1920 x 1440 pixels
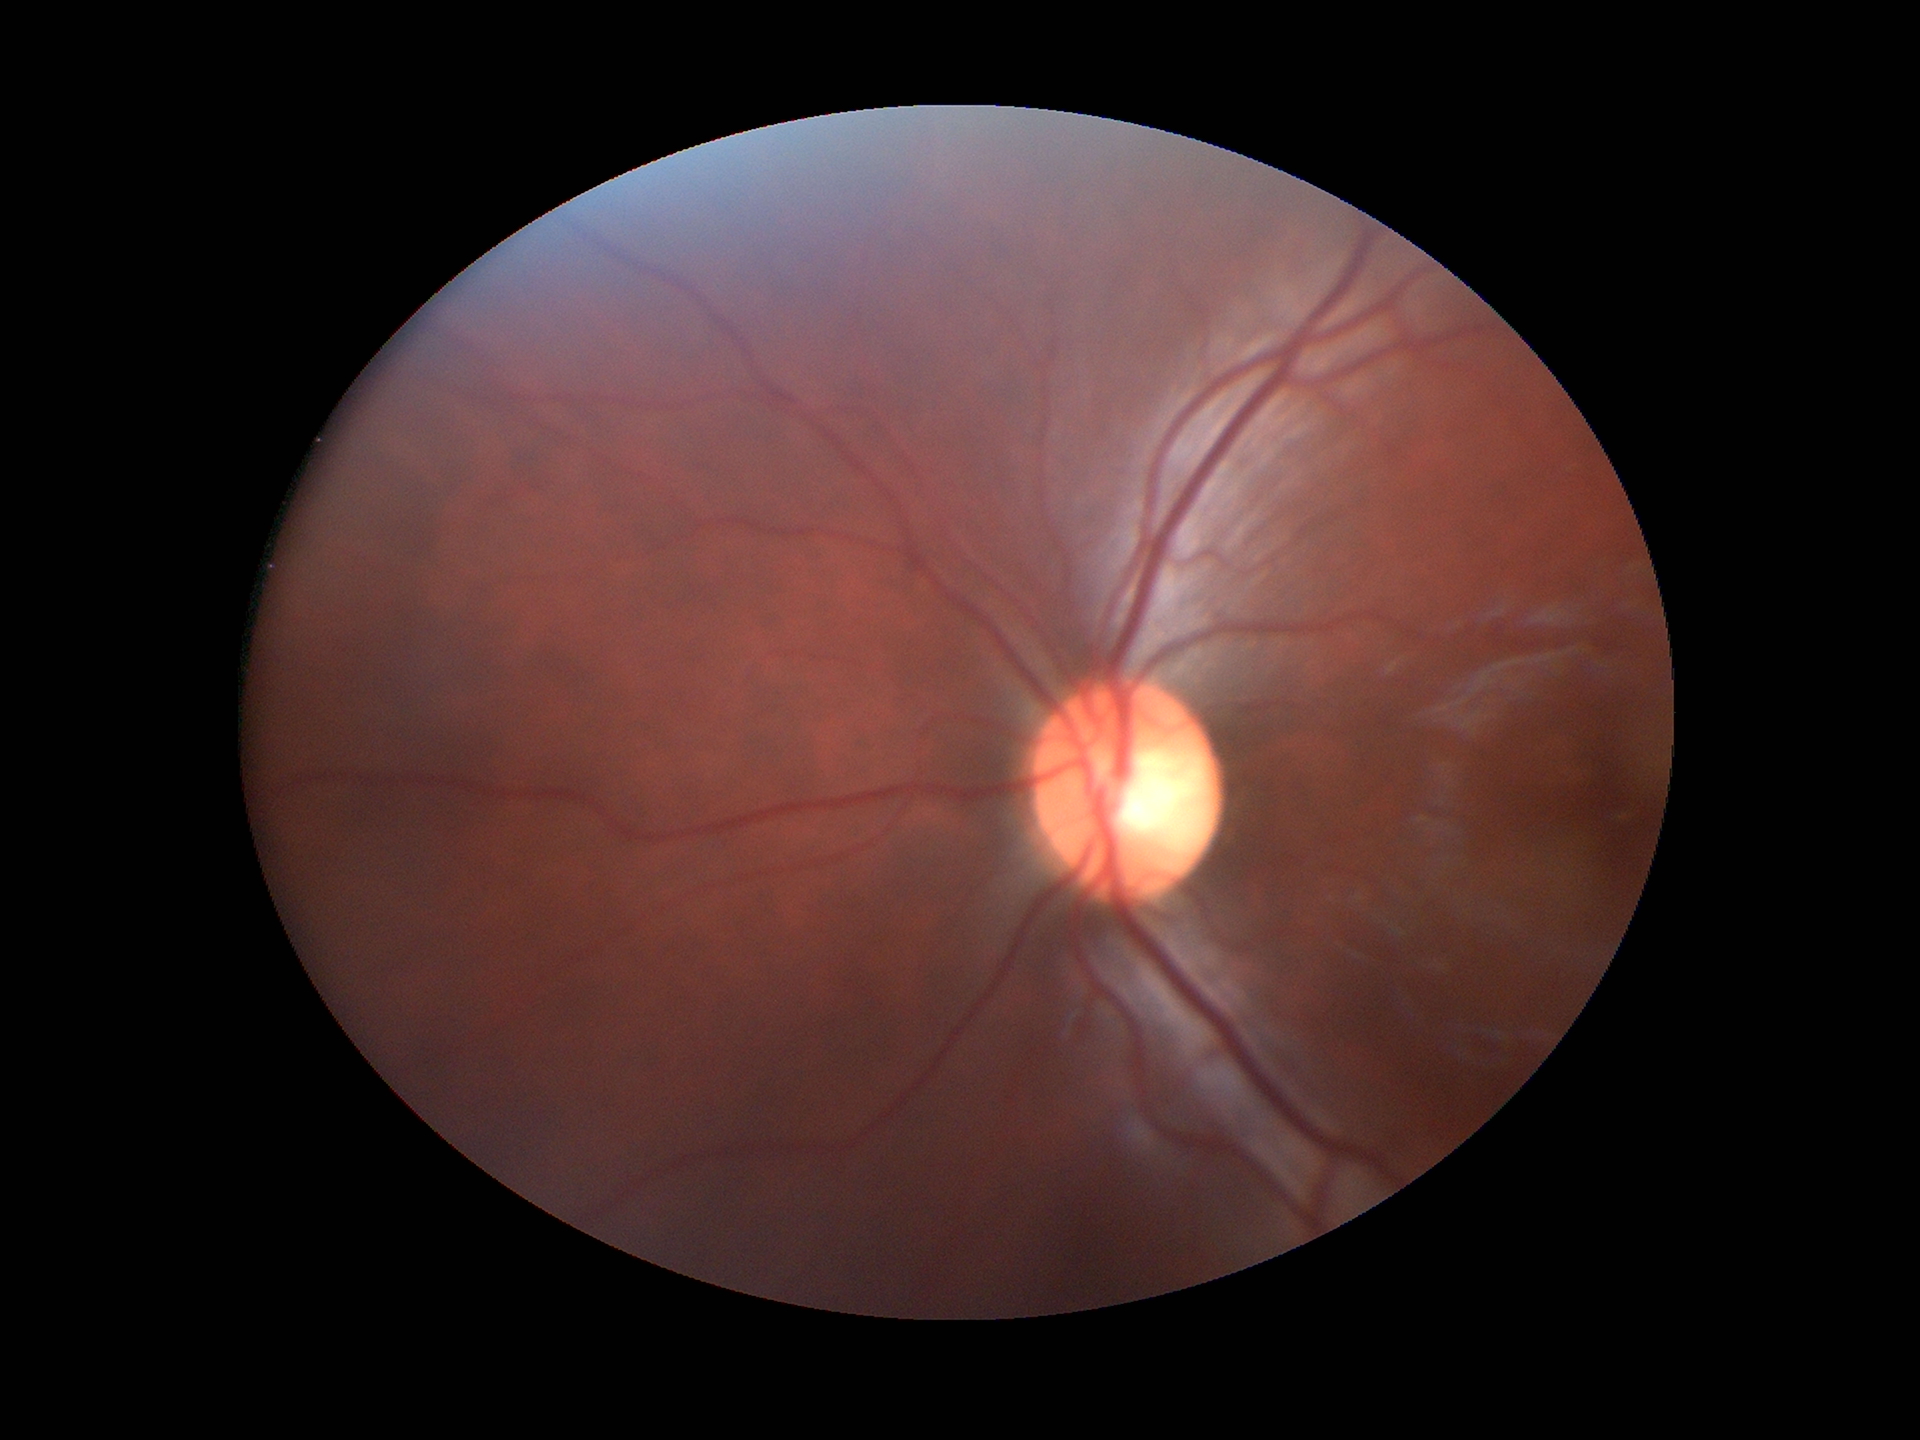

Glaucoma decision: no suspicious findings, vertical CDR (VCDR): 0.50.